Clarity RetCam 3, 130° FOV. Infant wide-field retinal image: 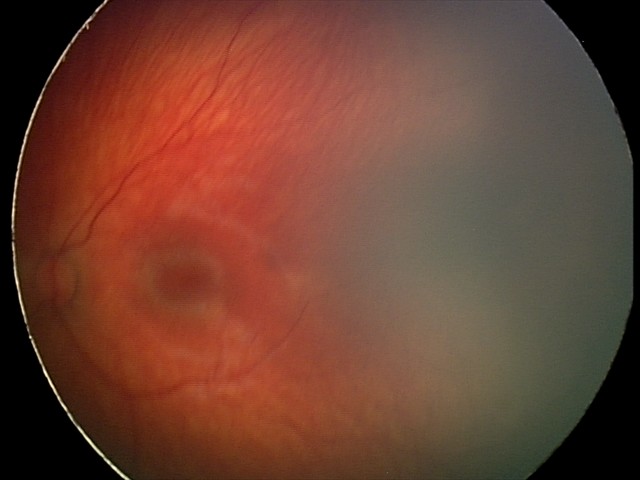

Series diagnosed as retinal hemorrhages.